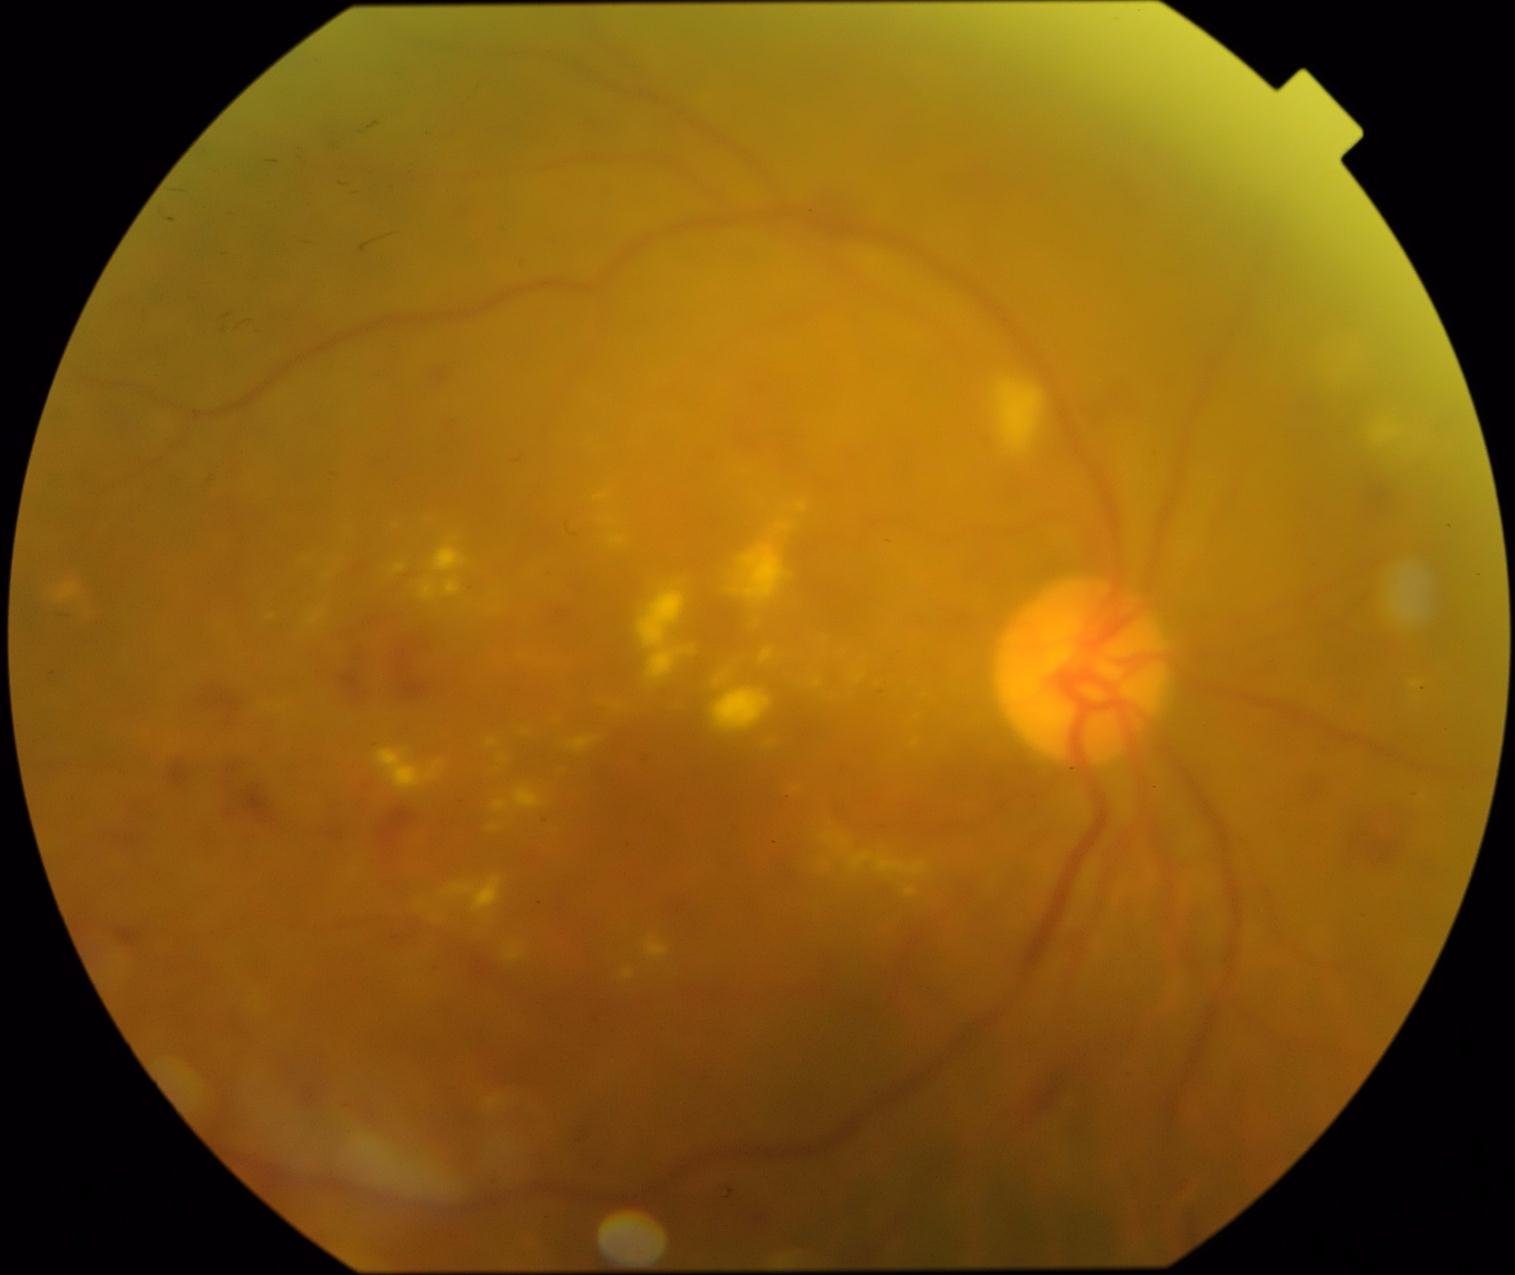
DR grade=moderate NPDR (2).